Color fundus image; 1932x1932; macula-centered field
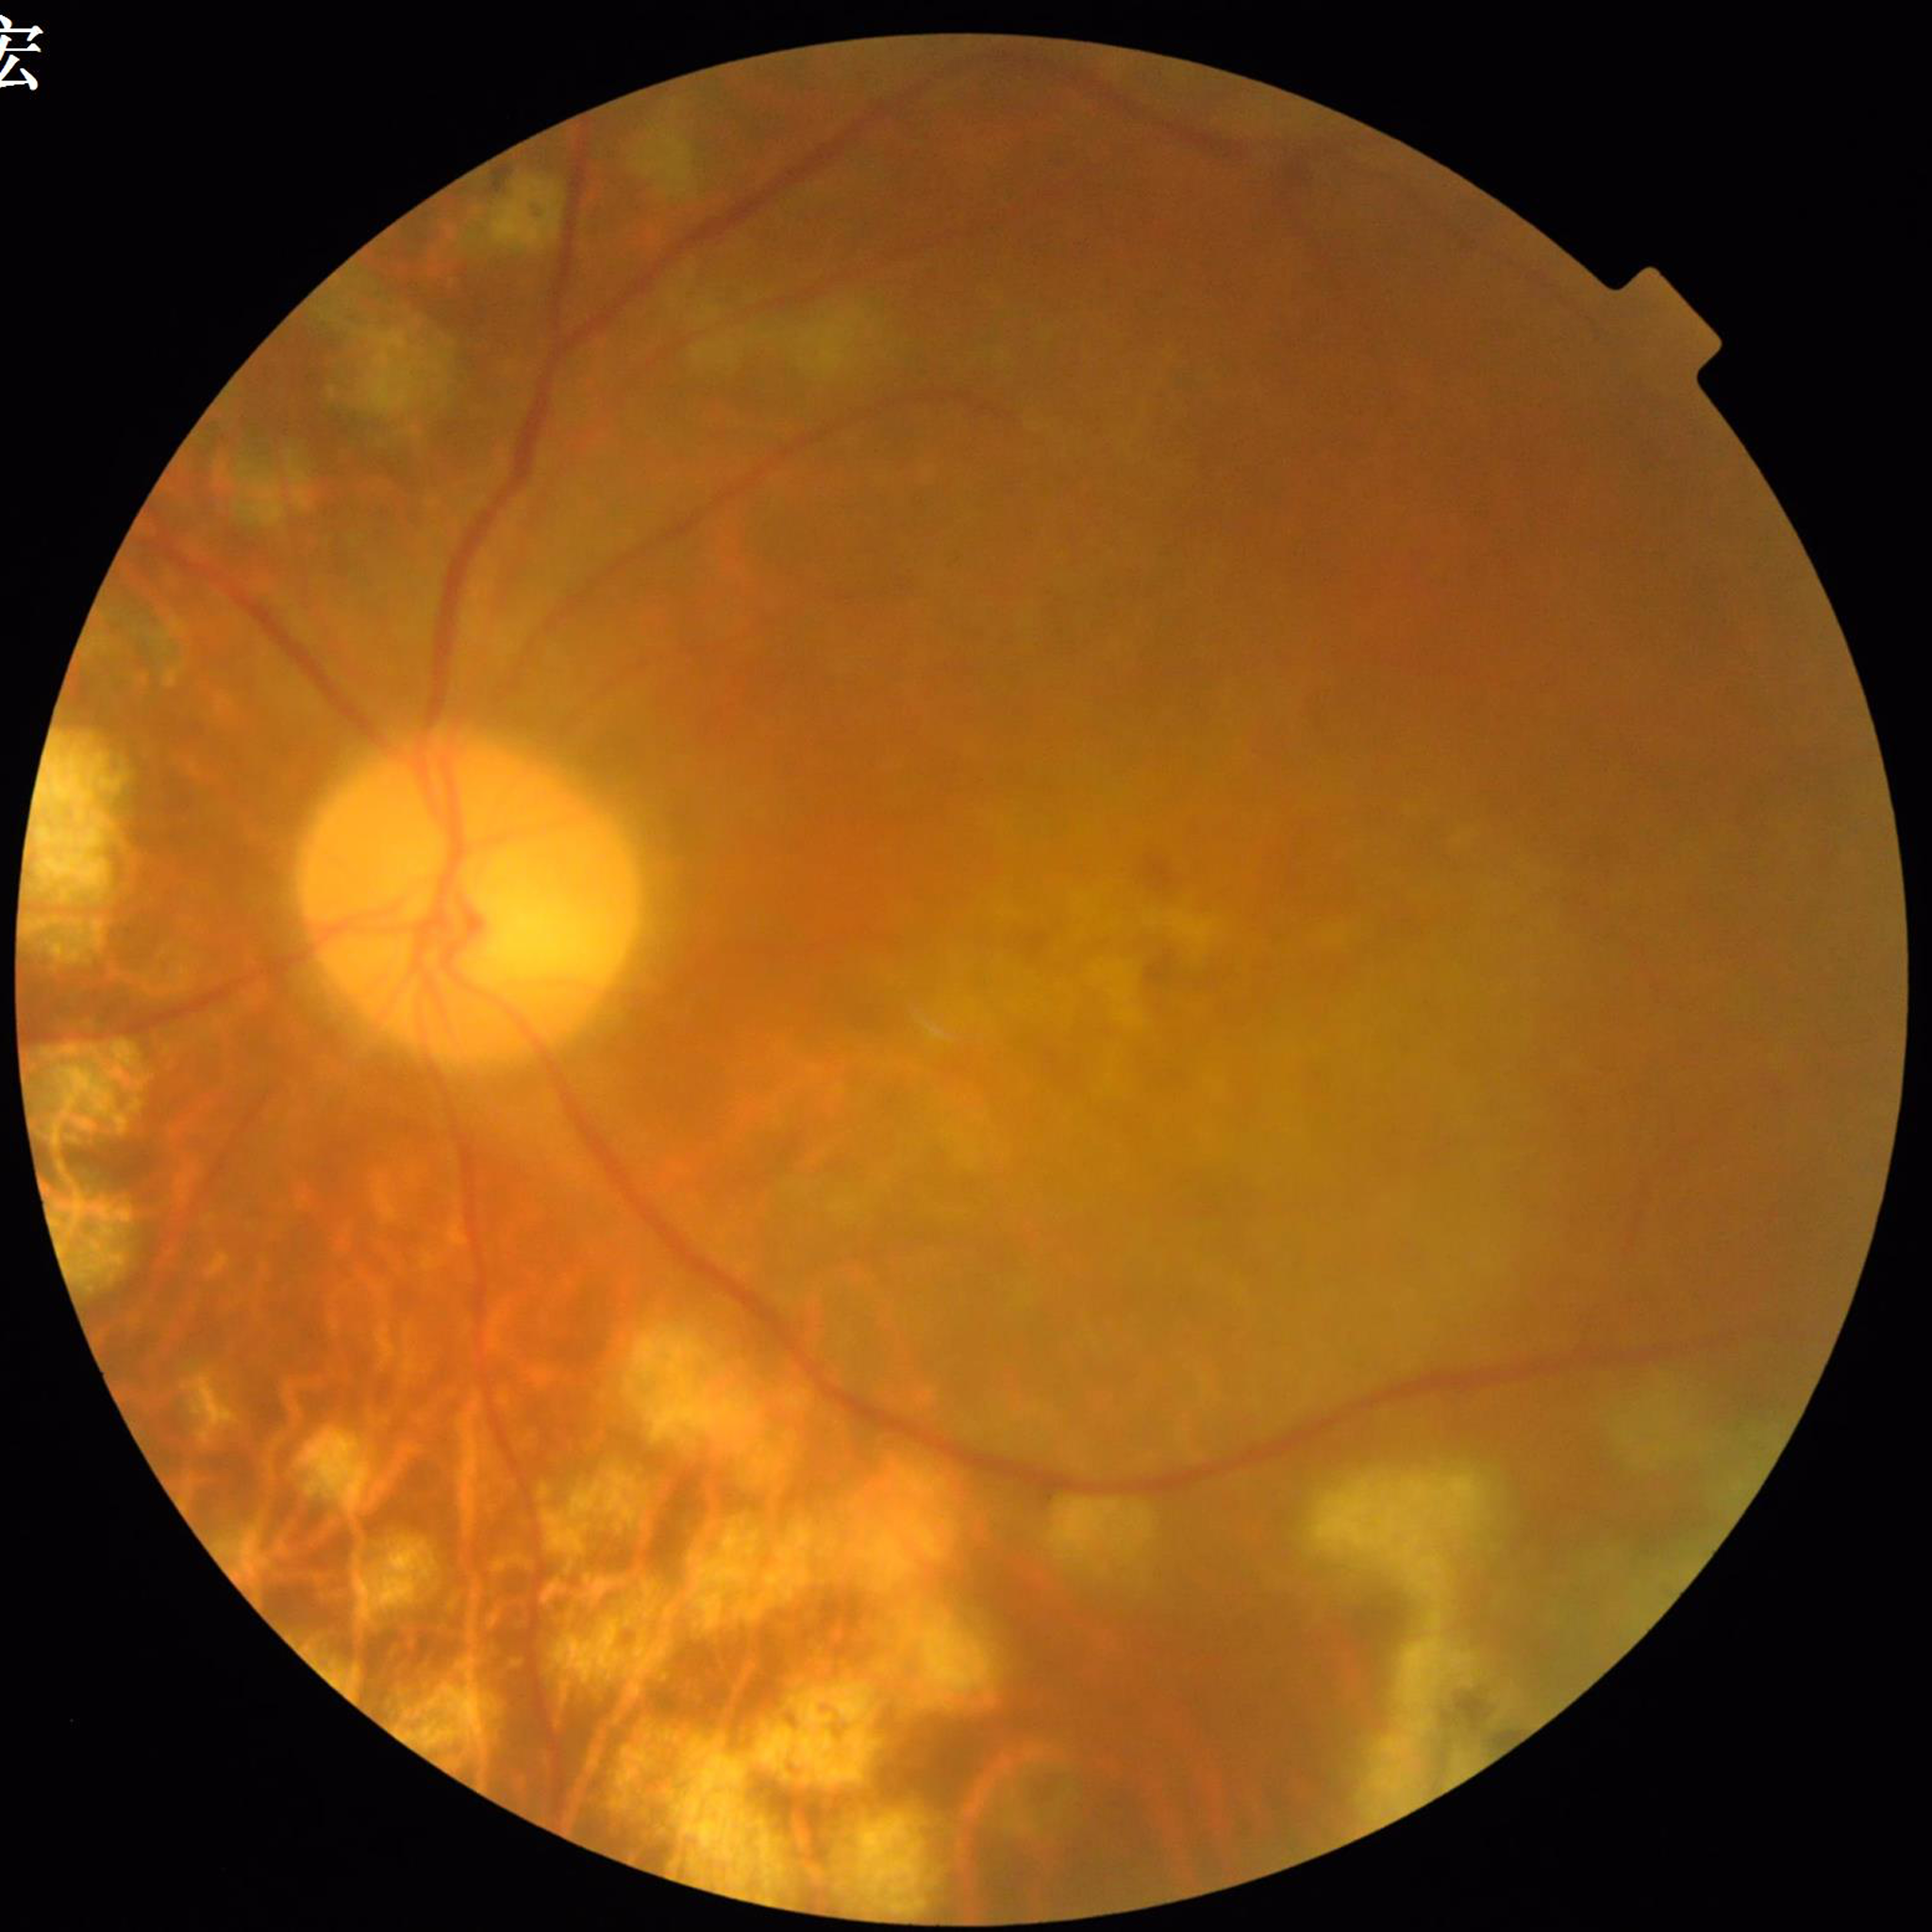
Automated quality assessment: blur present, illumination and color satisfactory, contrast adequate. Patient diagnosed with DR.